Wide-field contact fundus photograph of an infant · 640 x 480 pixels — 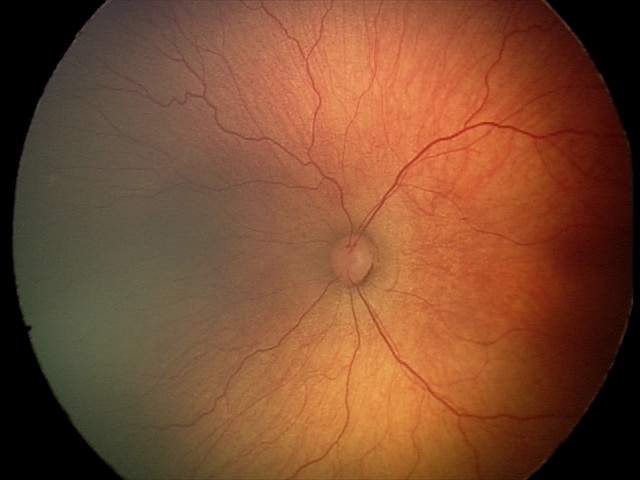 Finding = retinopathy of prematurity stage 2
plus disease = absent